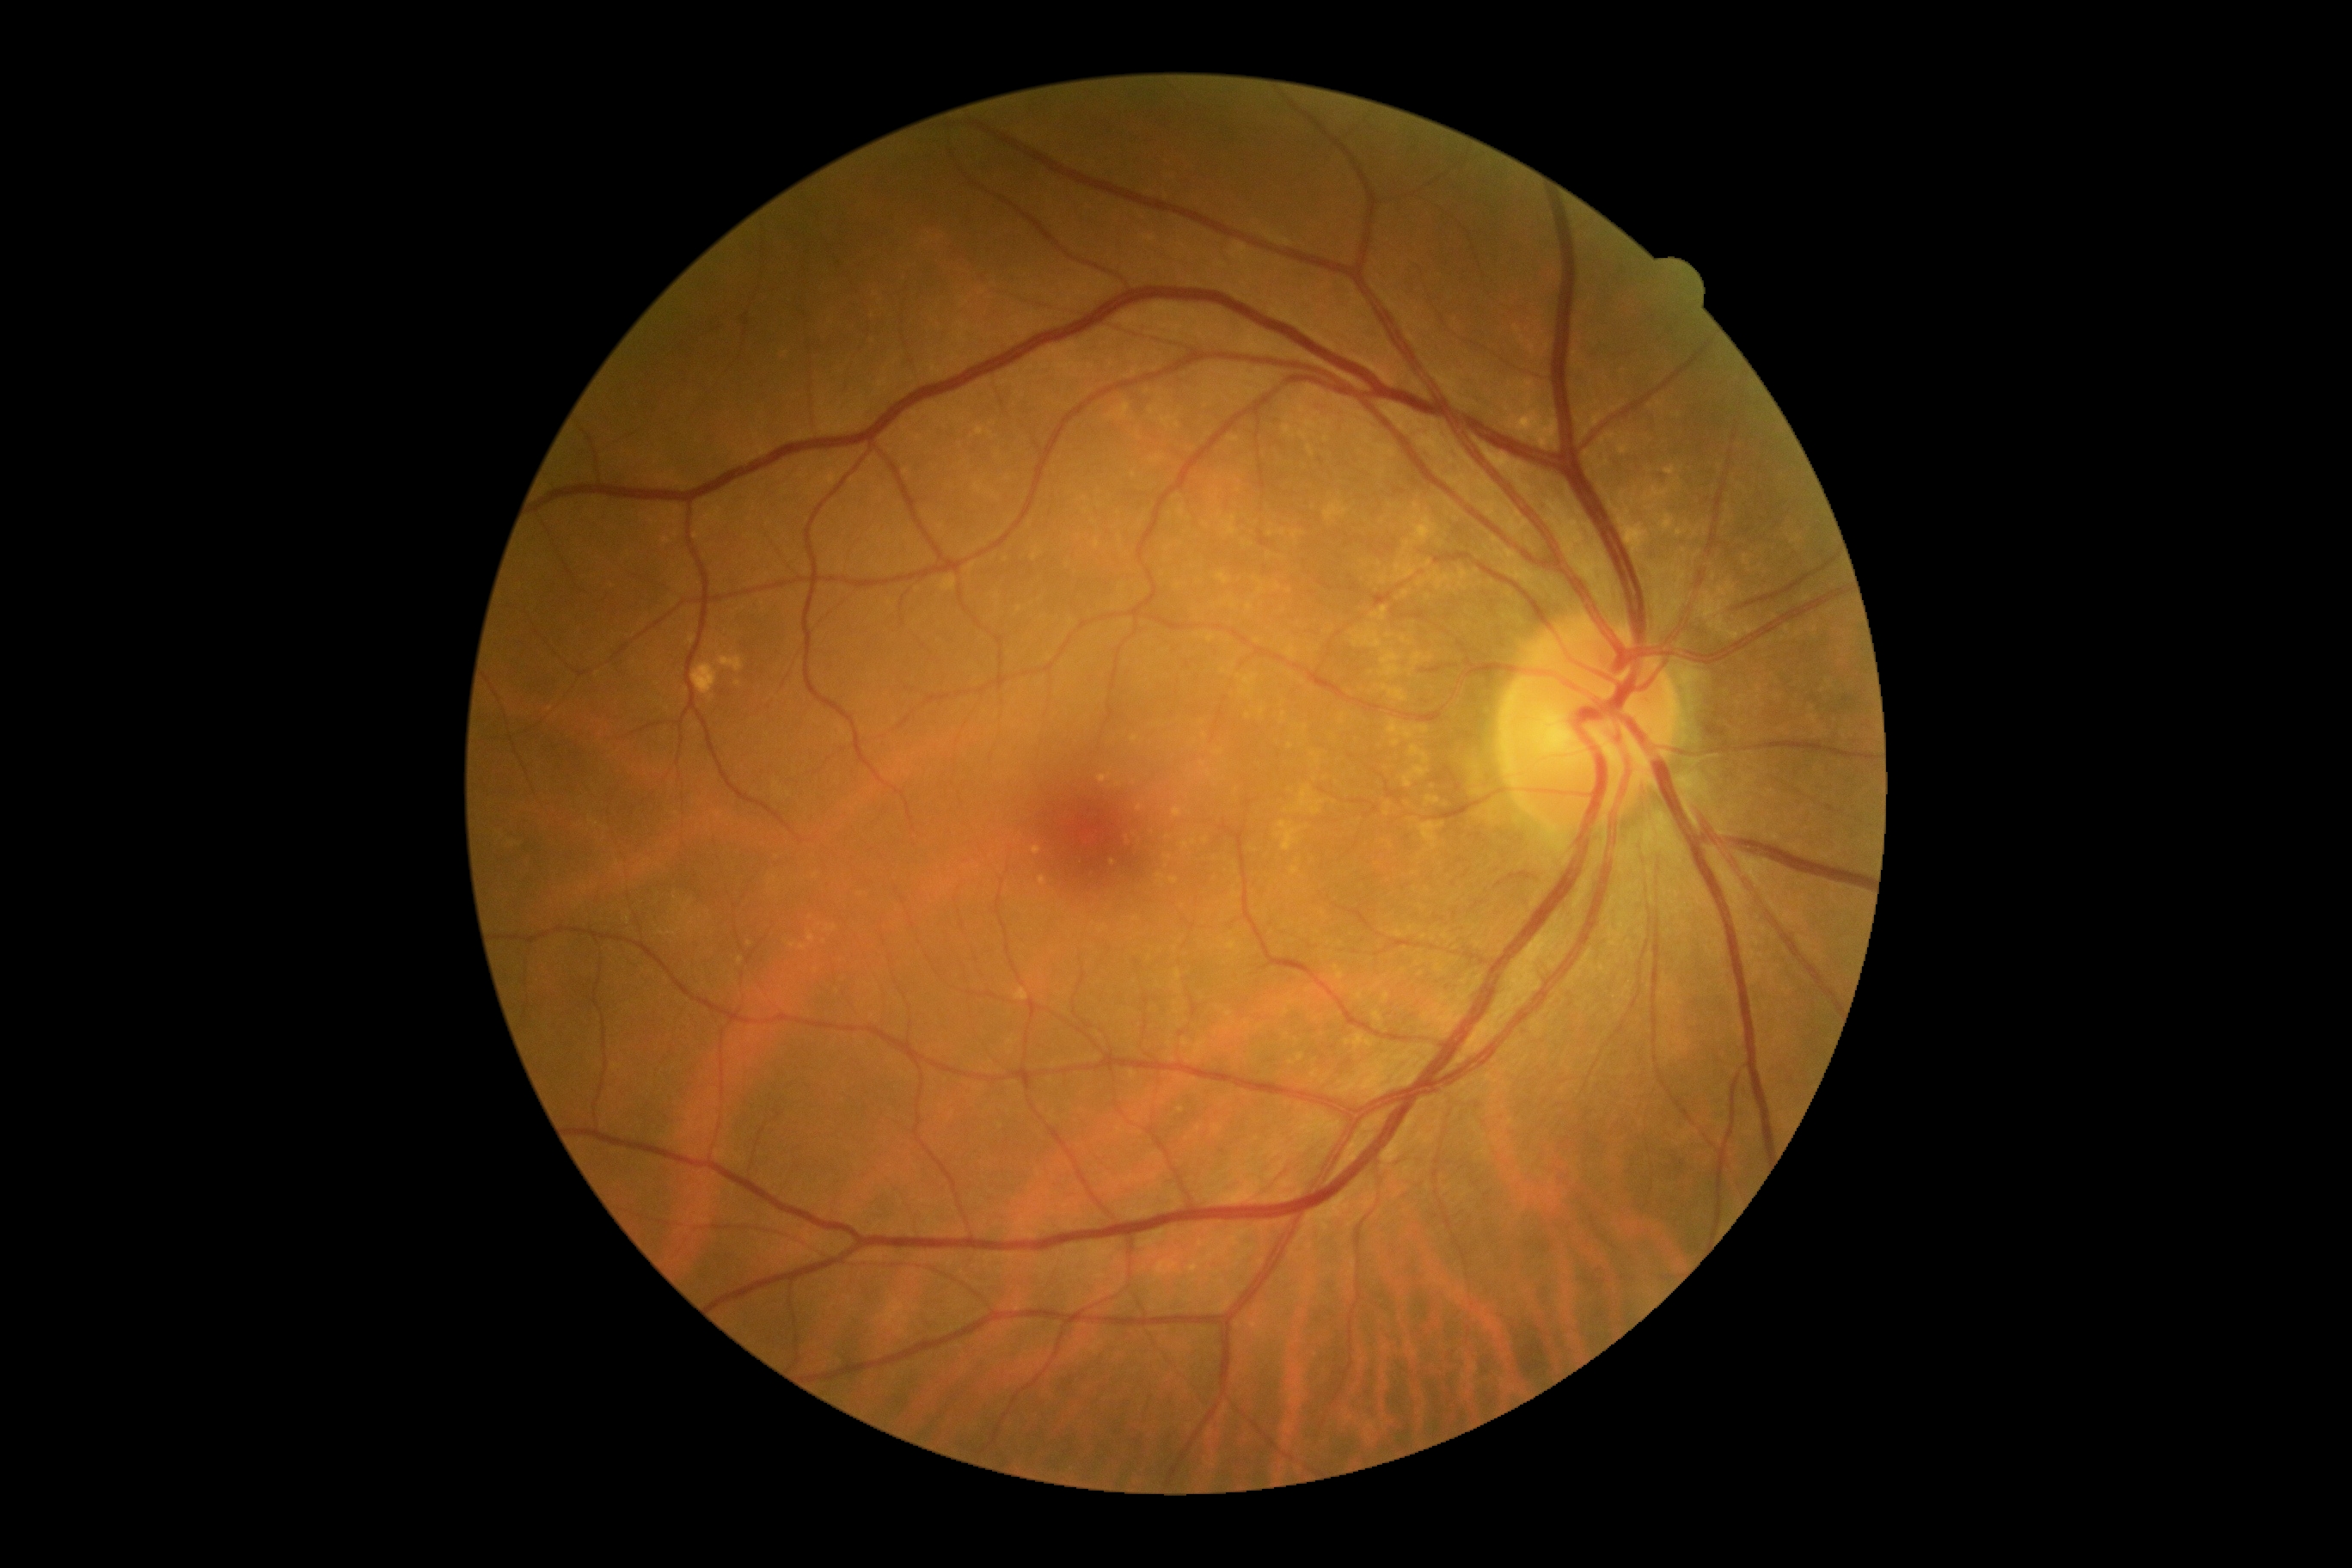

diabetic retinopathy grade = 0/4.